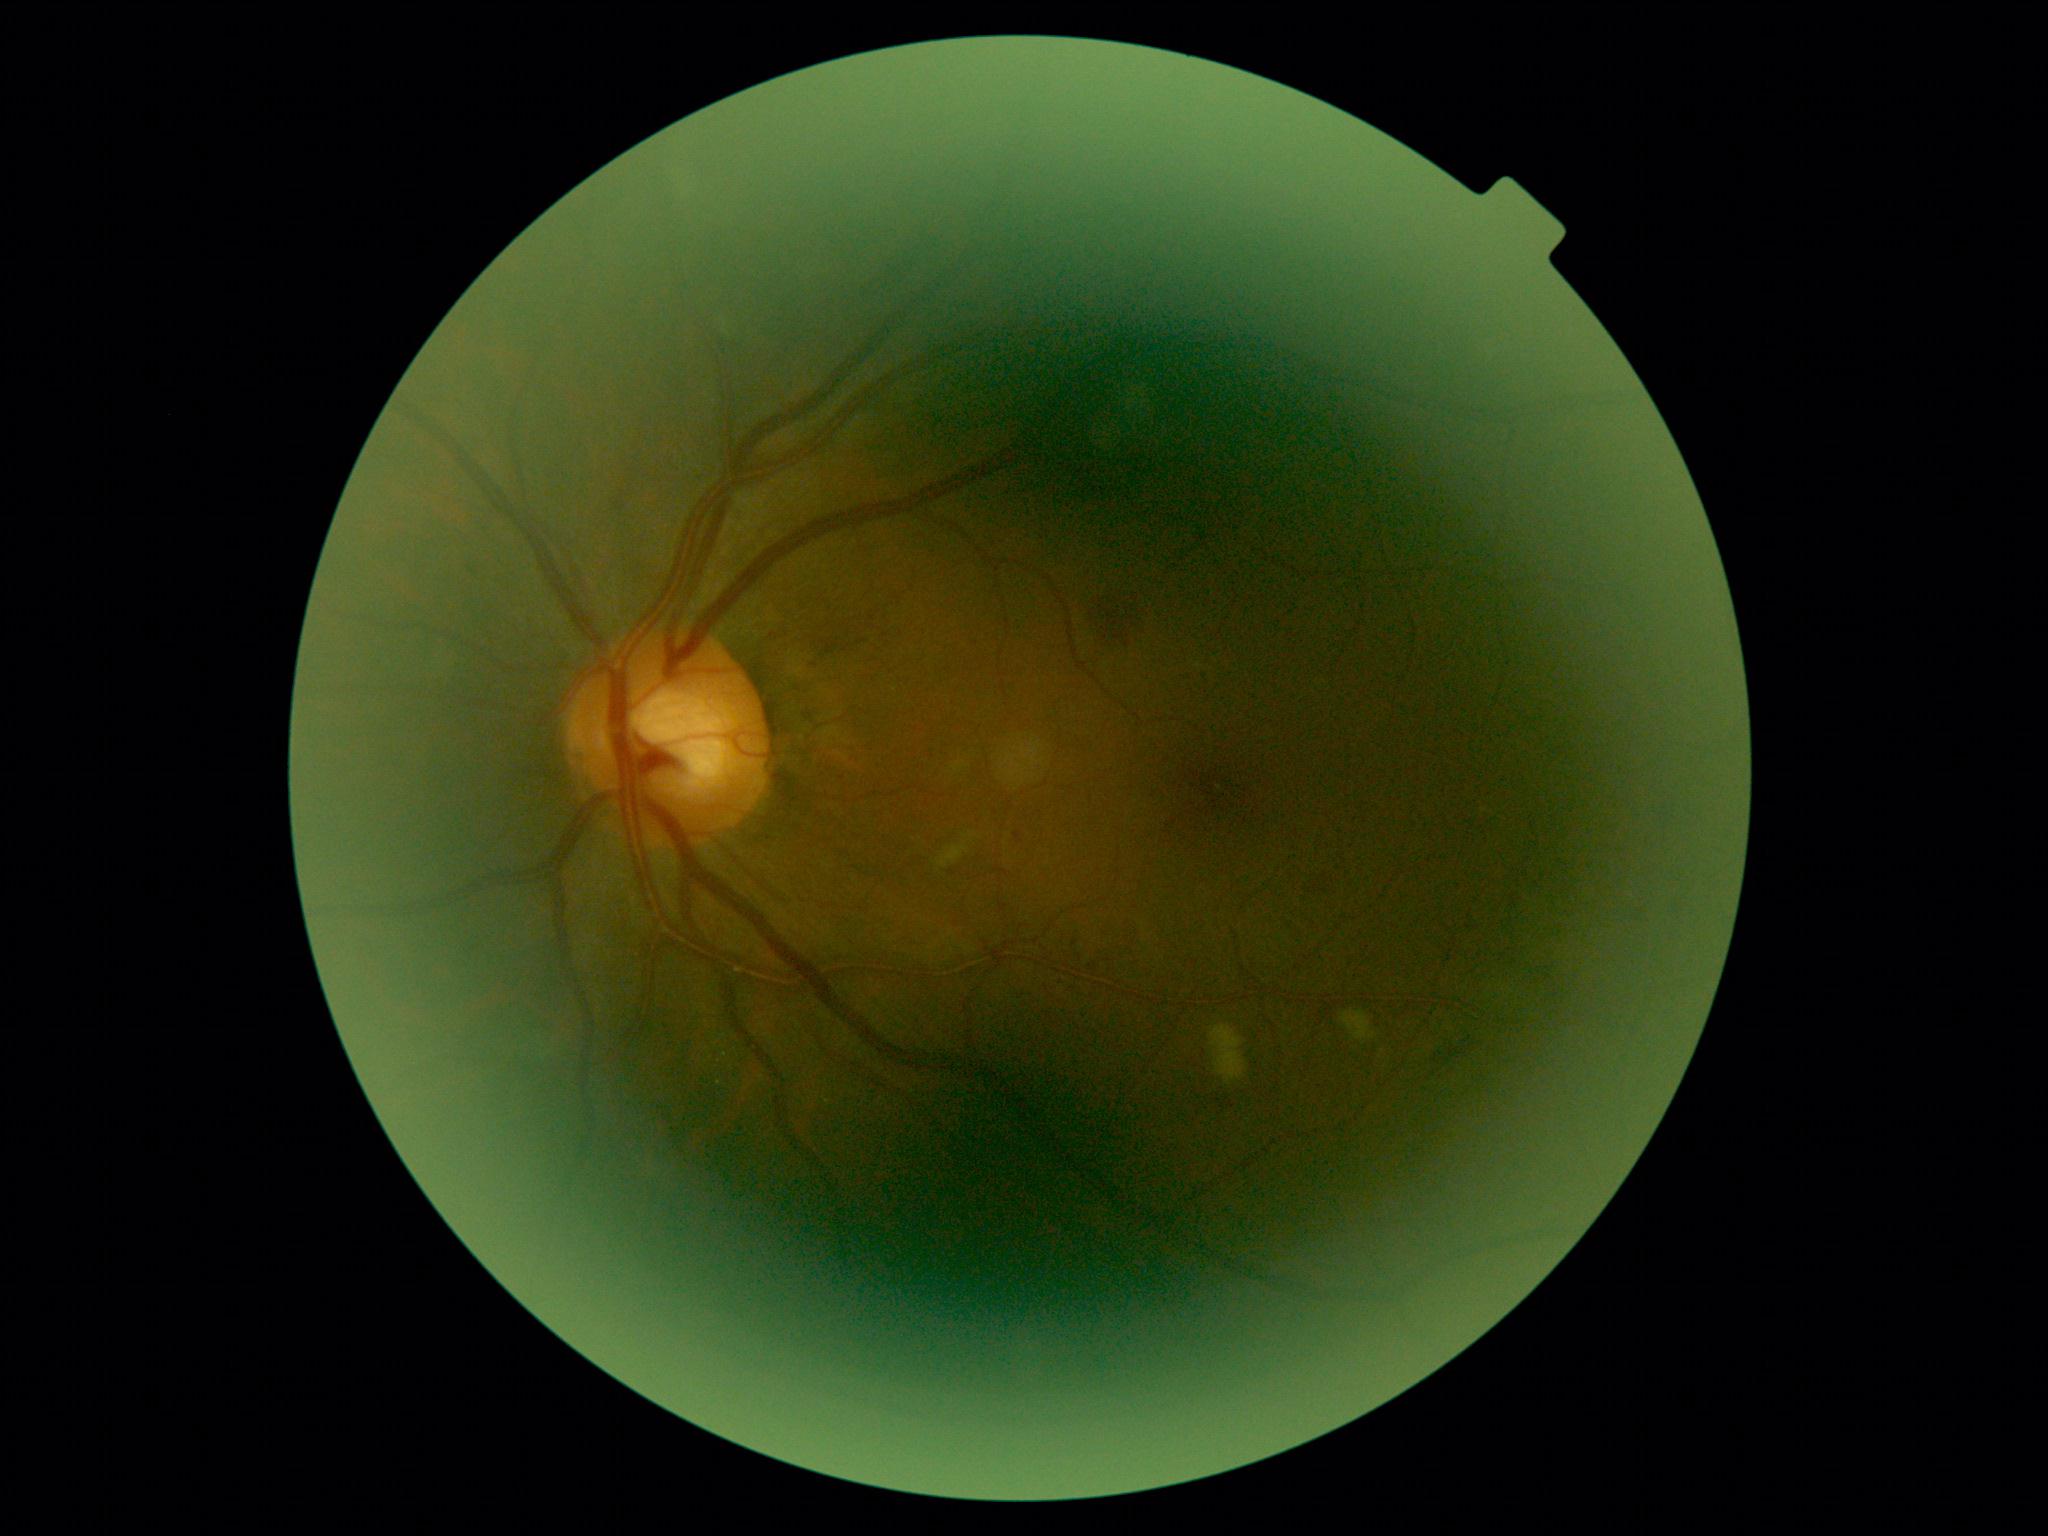 Diabetic retinopathy grade is 2/4.